DR severity per modified Davis staging:
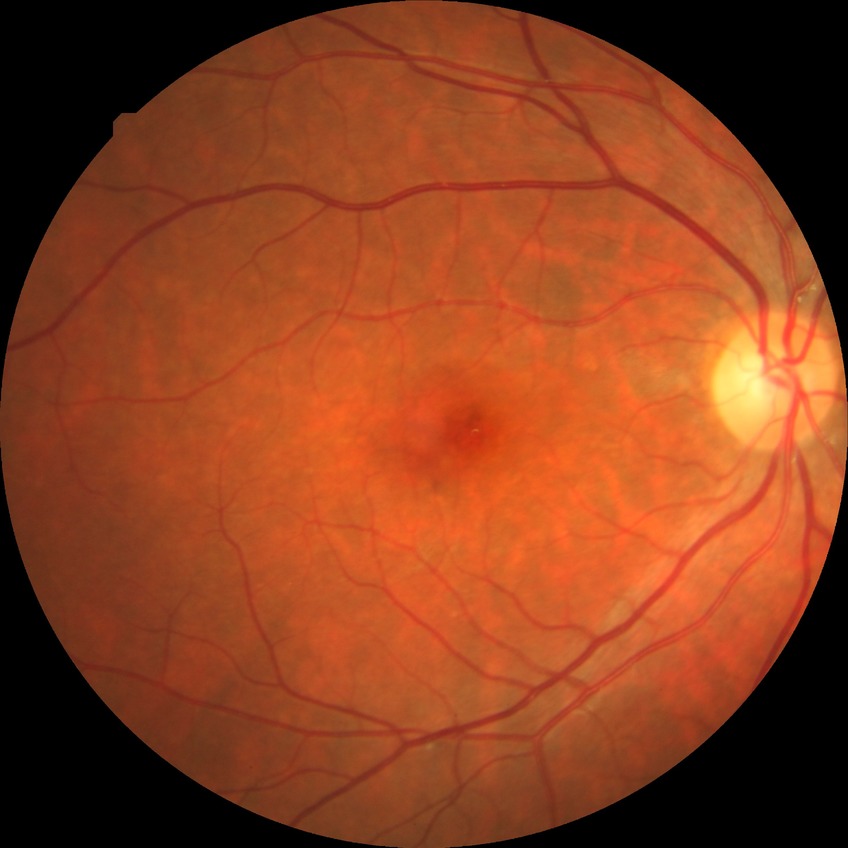
Modified Davis classification: no diabetic retinopathy.